Fundus photo.
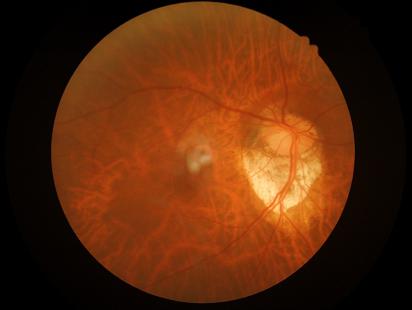   illumination: suboptimal
  contrast: adequate
  overall_quality: adequate
  clarity: good